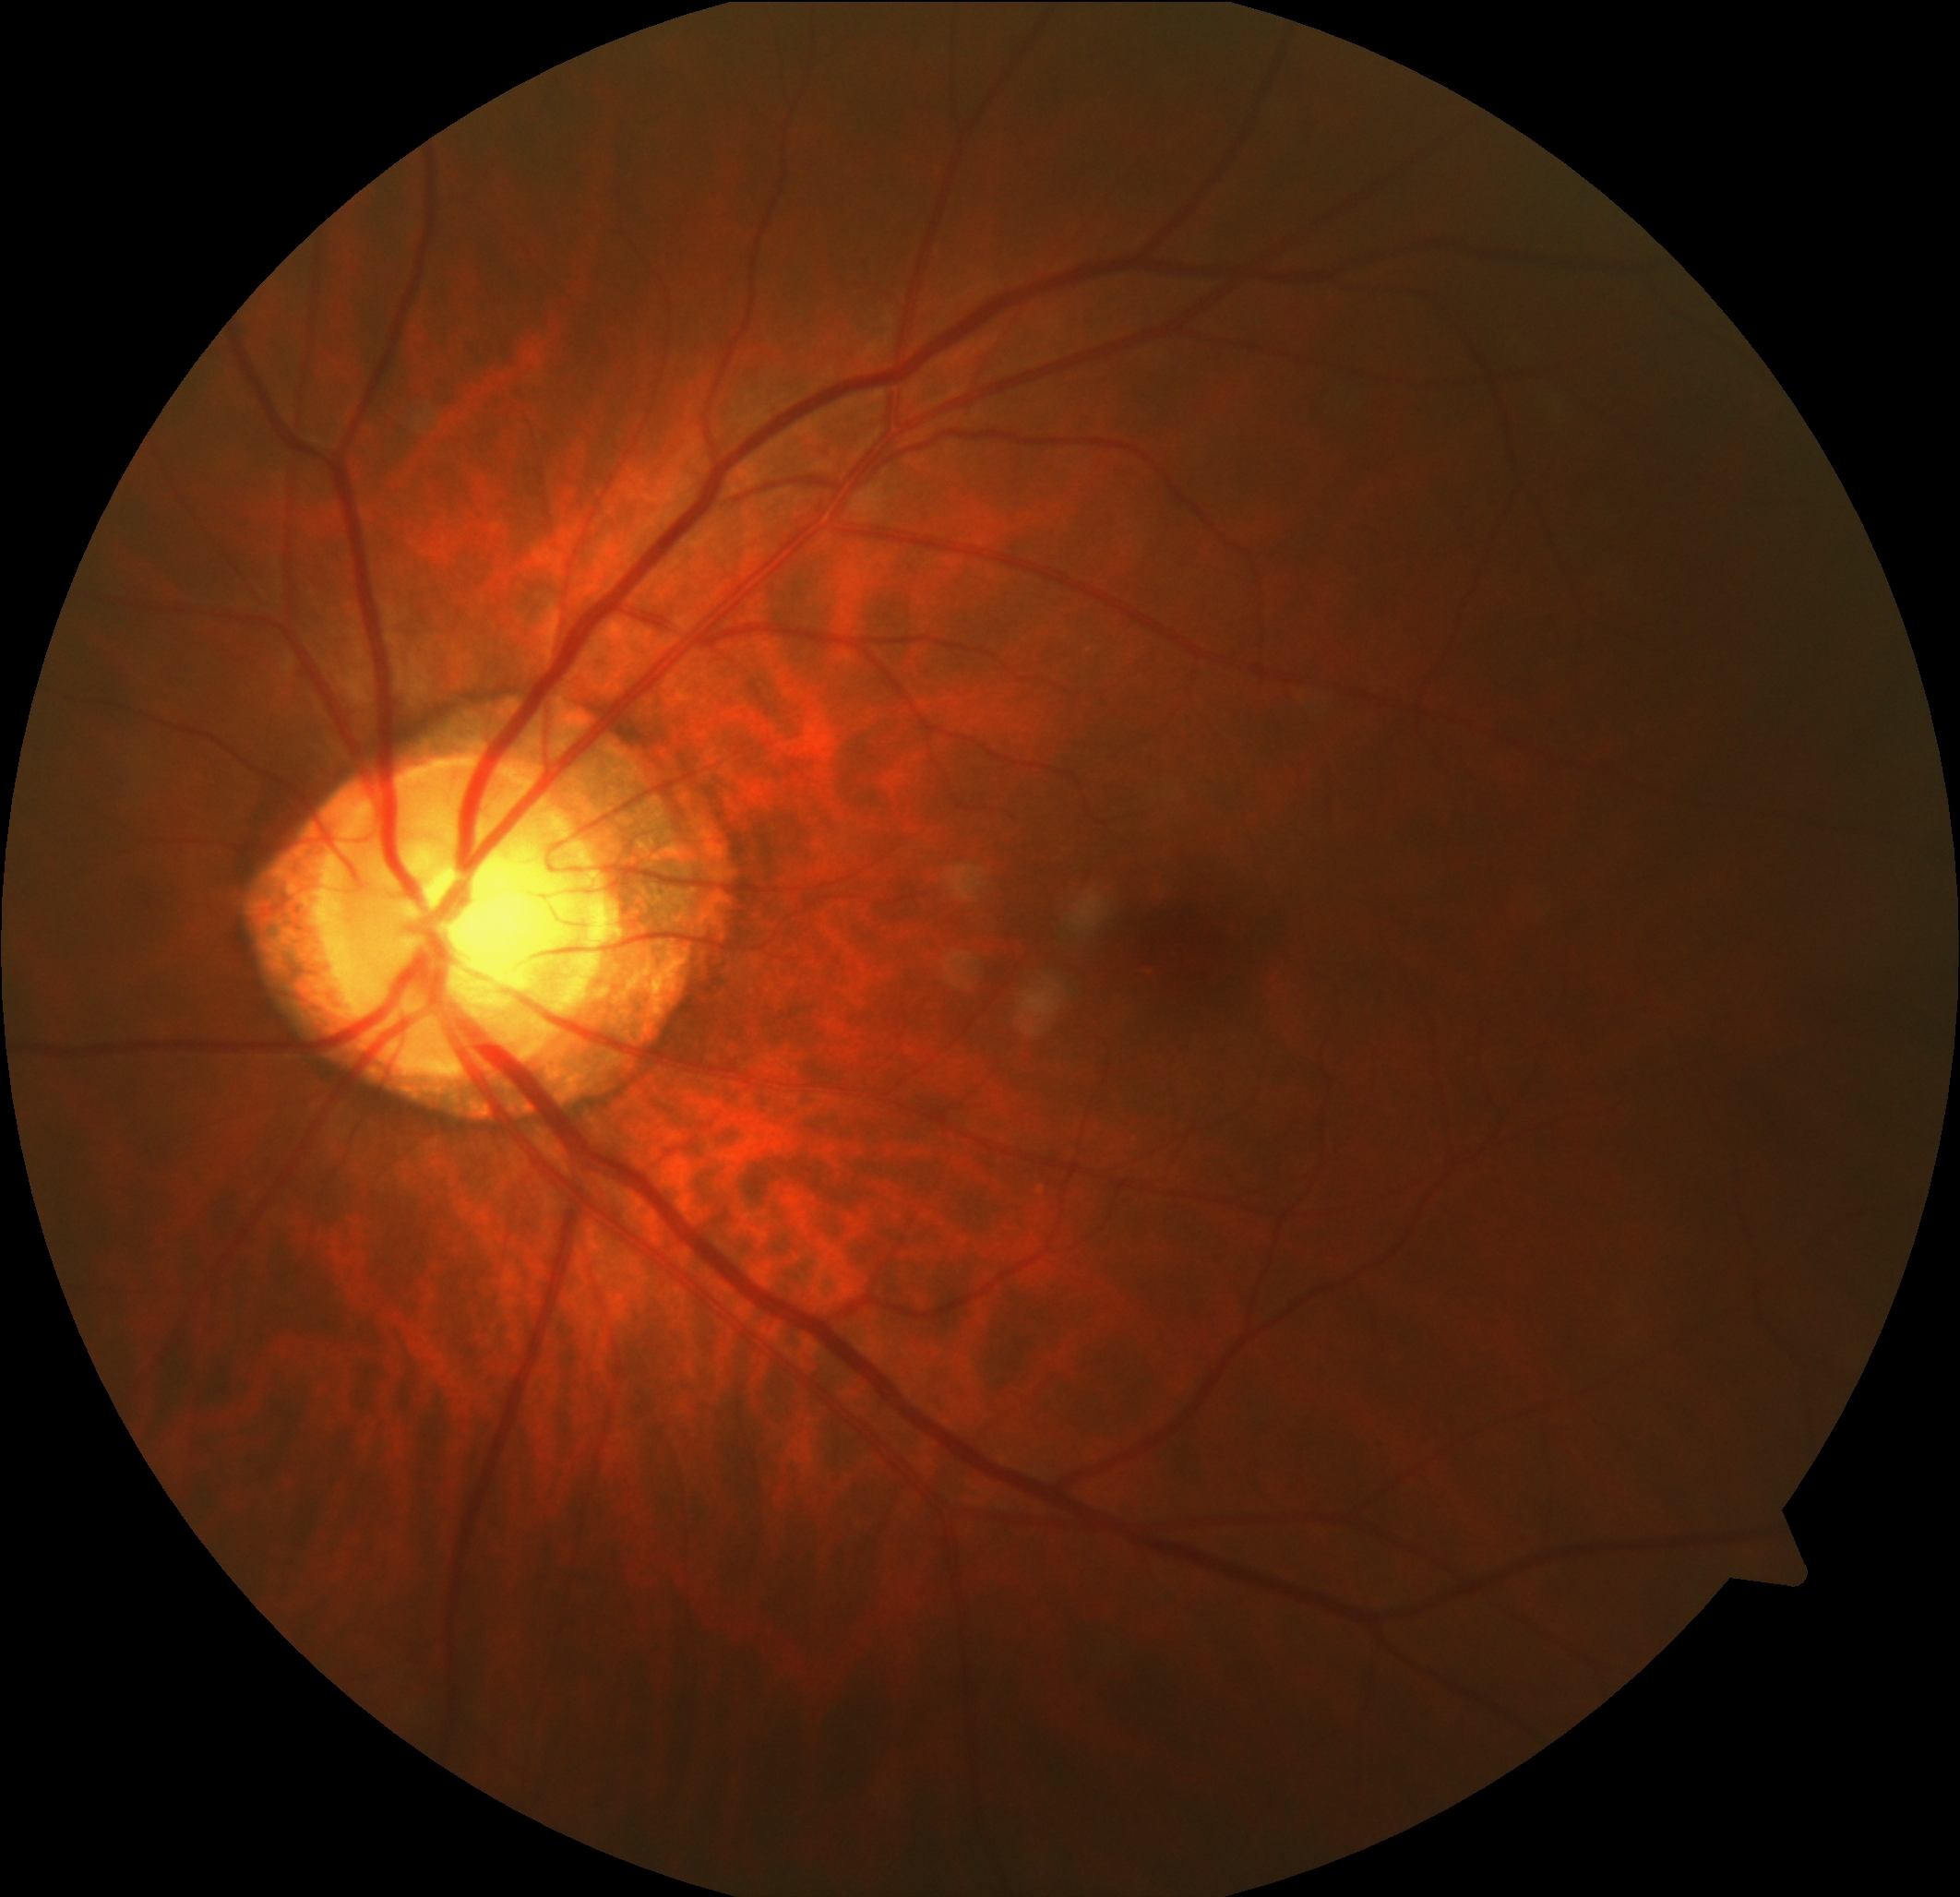
DR stage: no apparent retinopathy (grade 0).